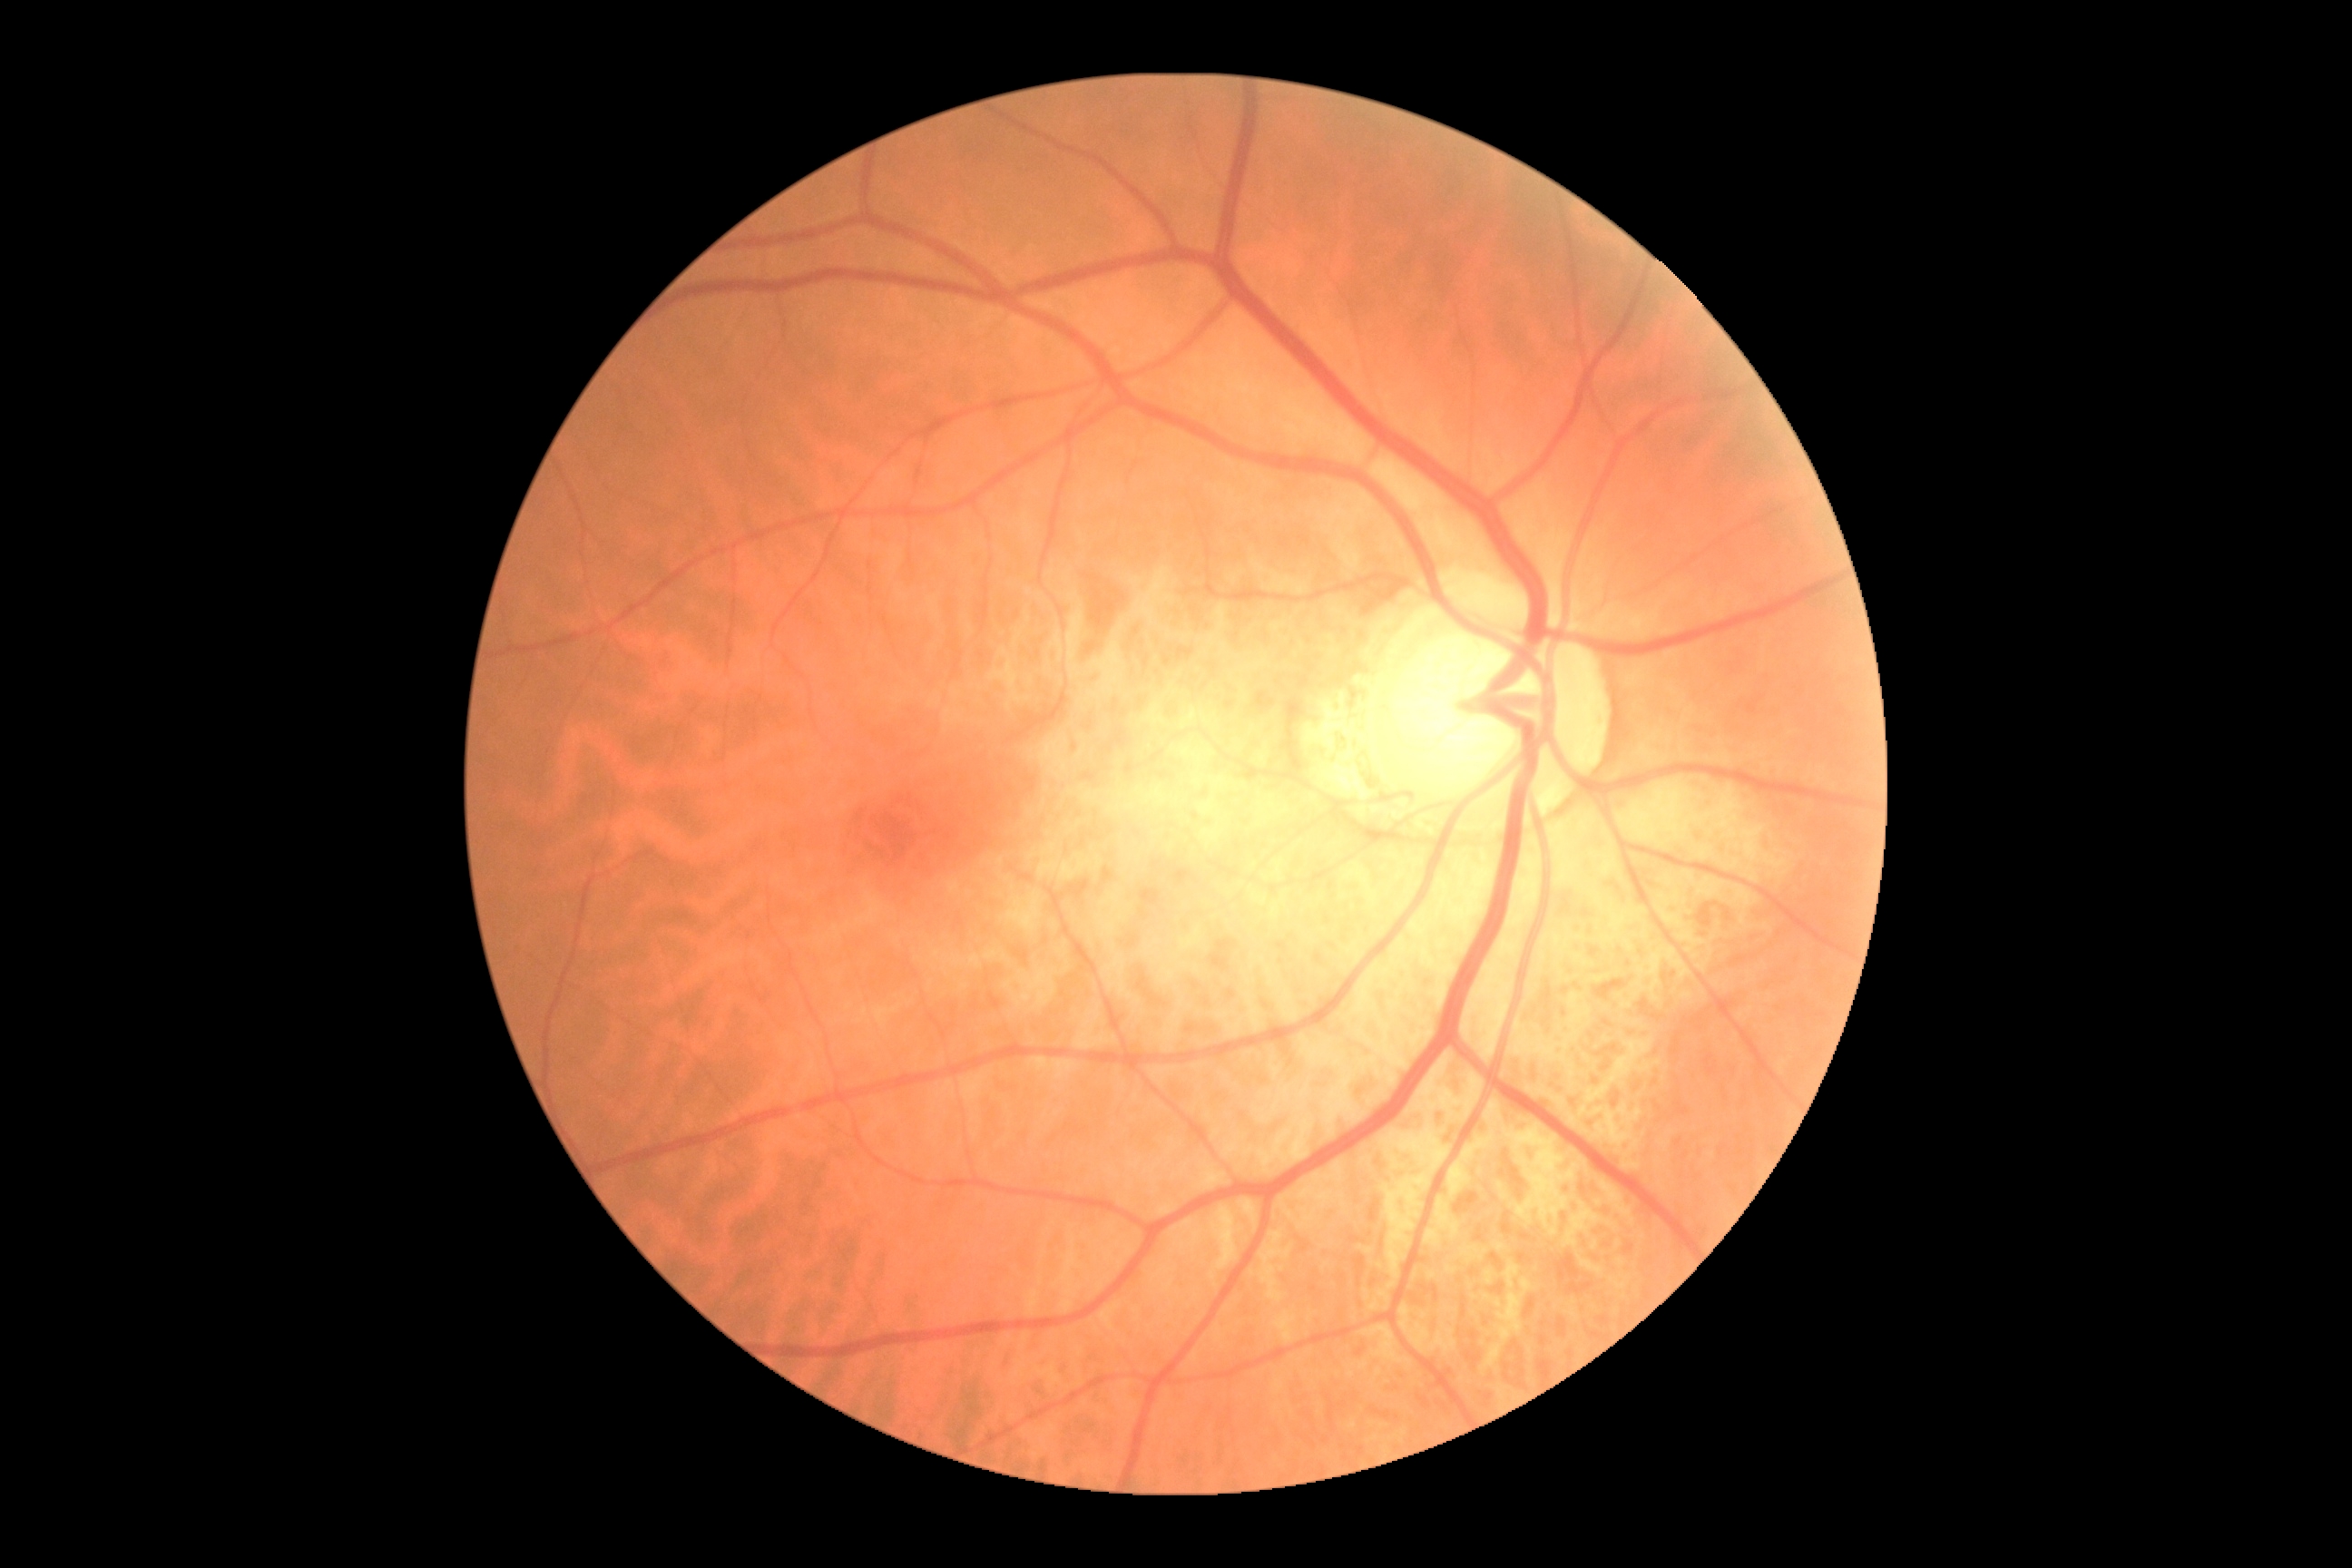
DR grade: no apparent diabetic retinopathy (0). No apparent diabetic retinopathy.